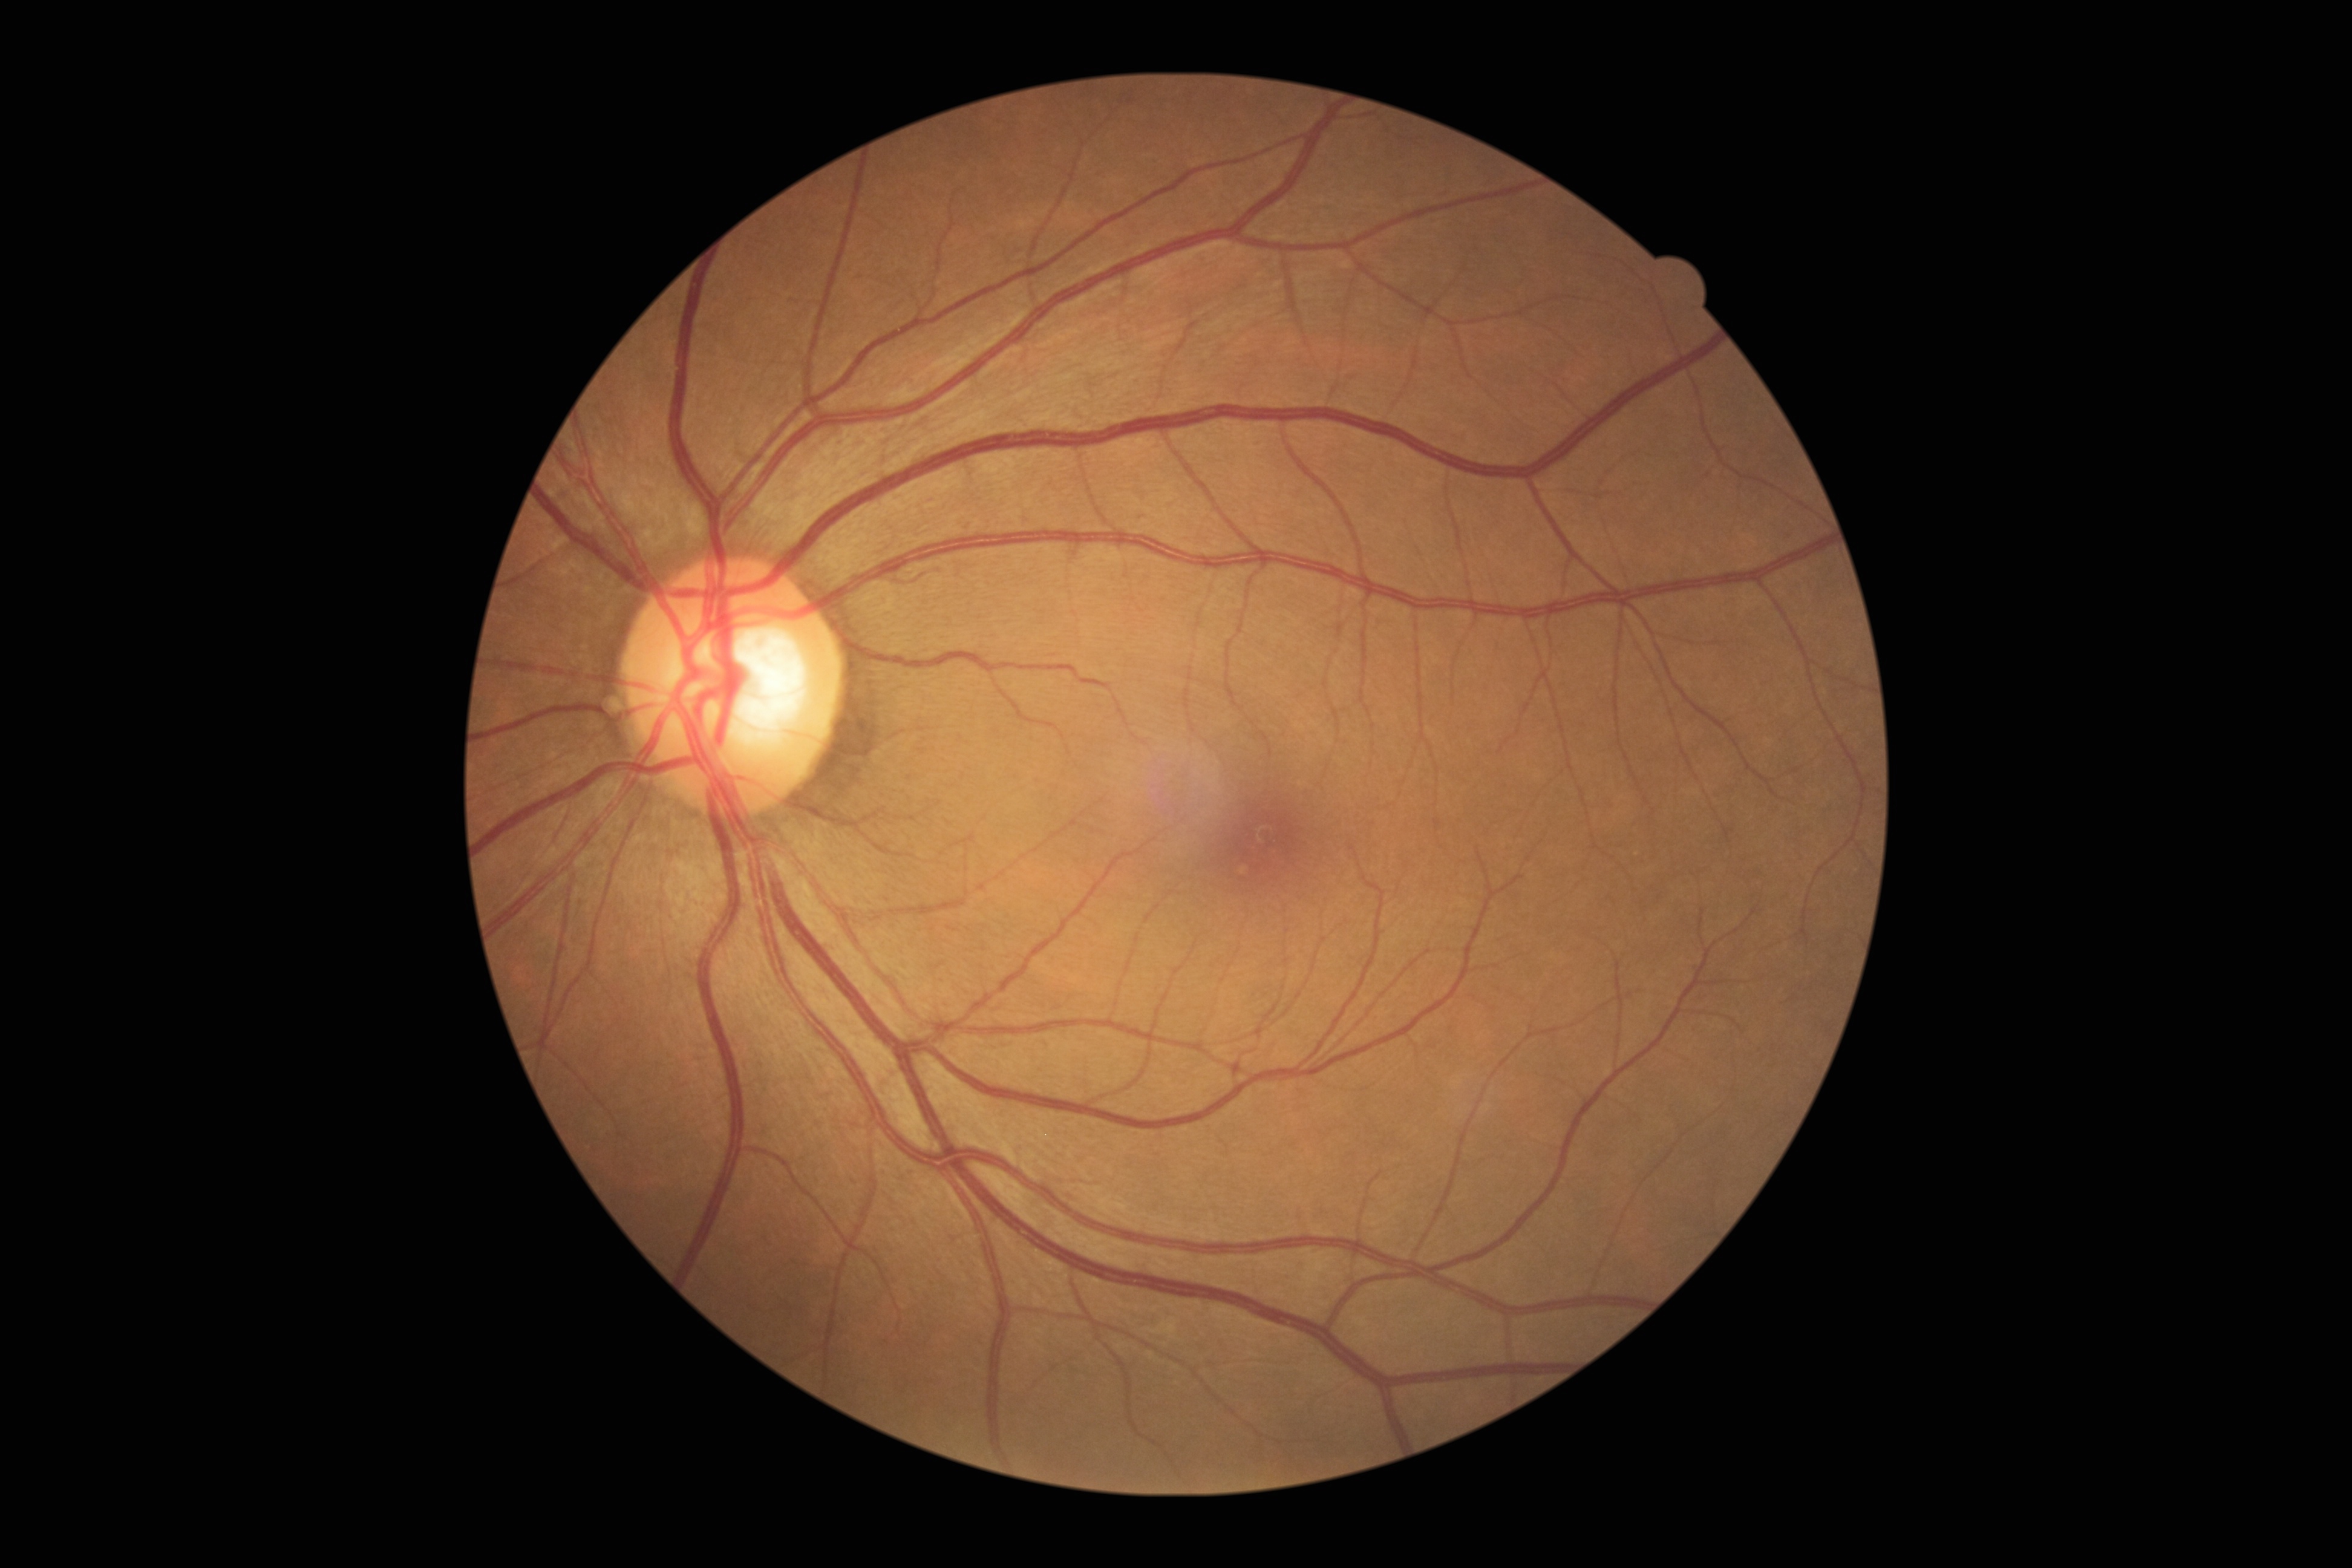

No DR findings. DR is no apparent retinopathy (grade 0).